640x480px. Captured with the Clarity RetCam 3 (130° field of view). RetCam wide-field infant fundus image.
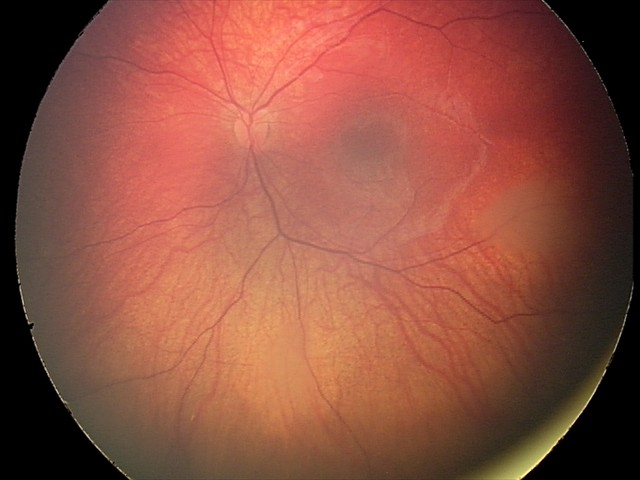
Impression: retinal astrocytic hamartoma.